Infant wide-field fundus photograph · 1440x1080
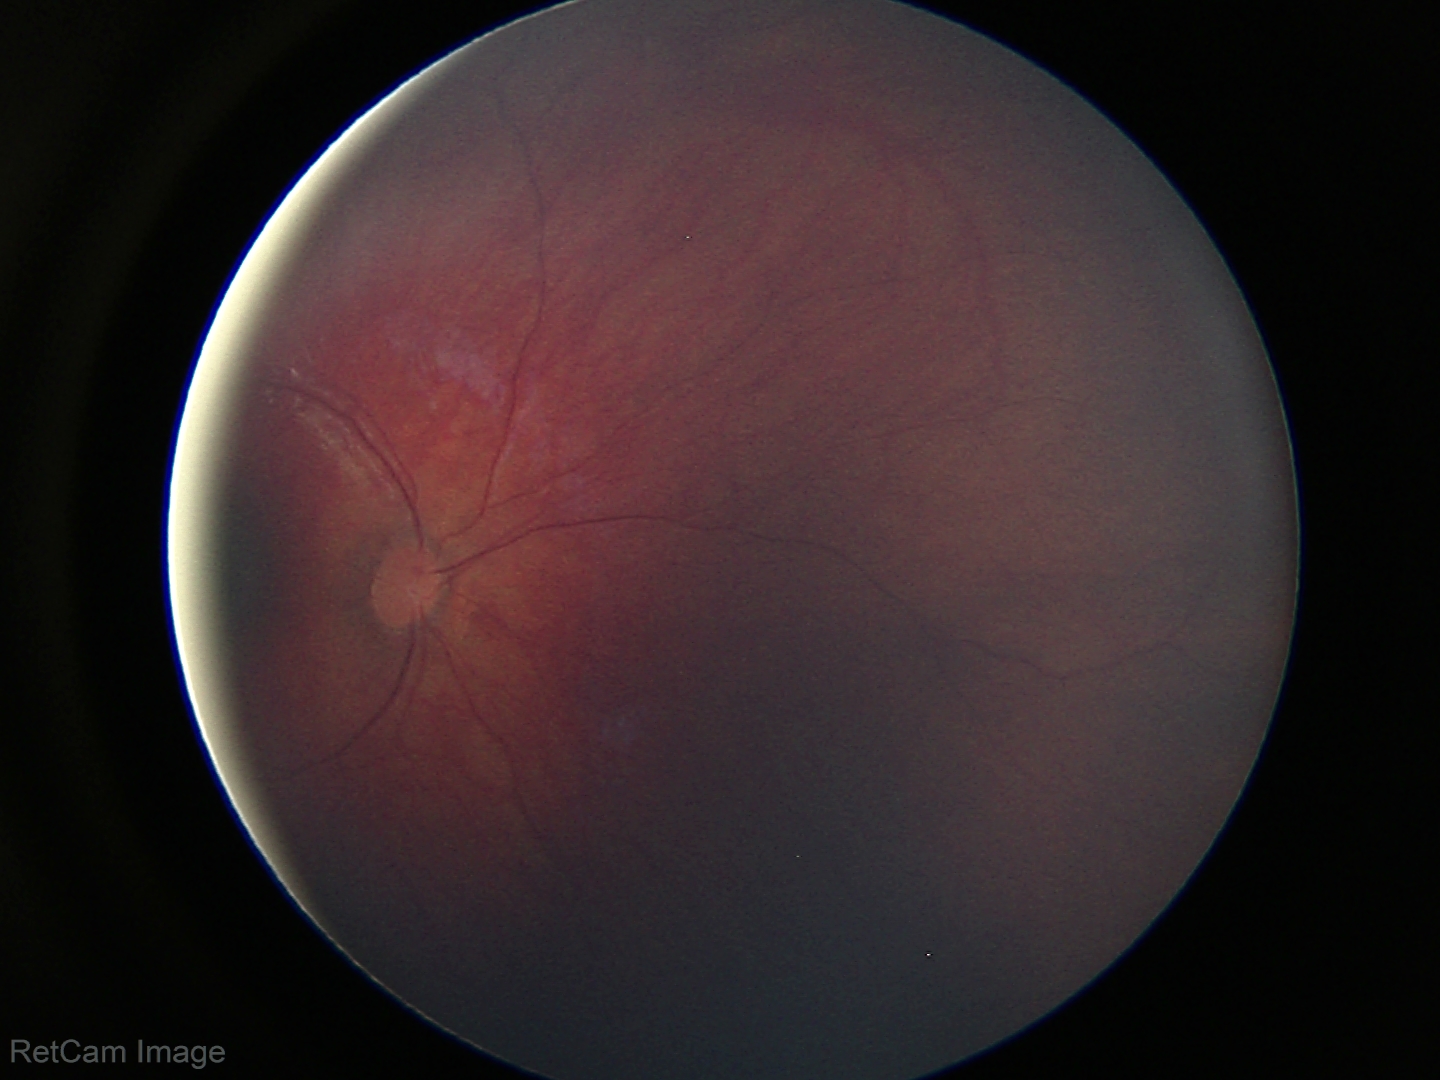 No retinal pathology identified on screening.